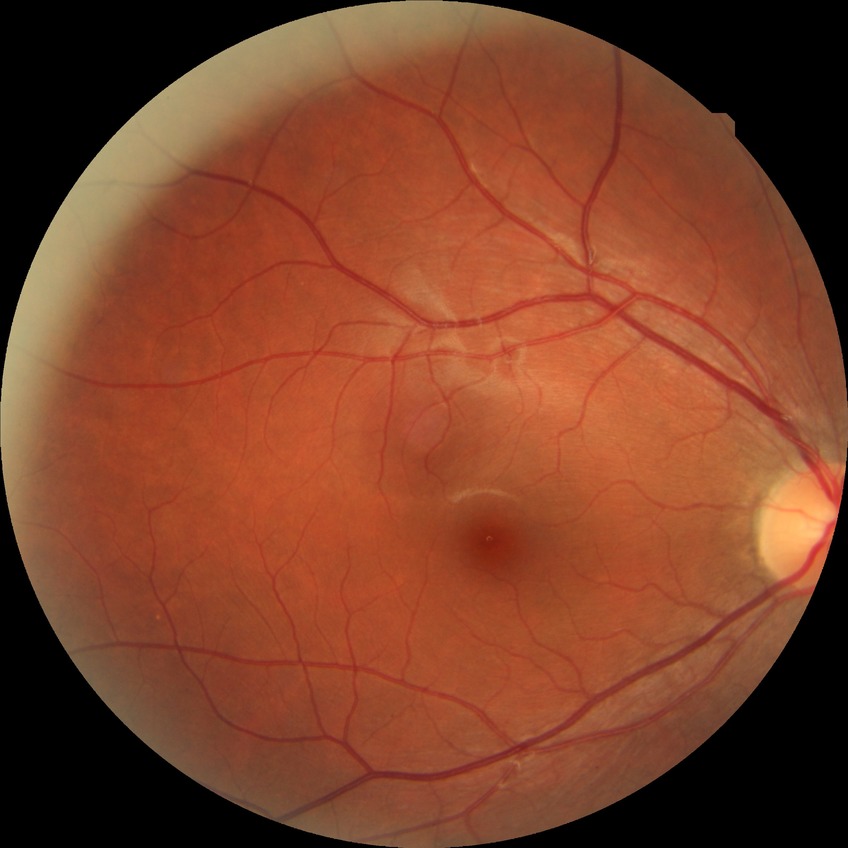

Retinopathy stage: no diabetic retinopathy.